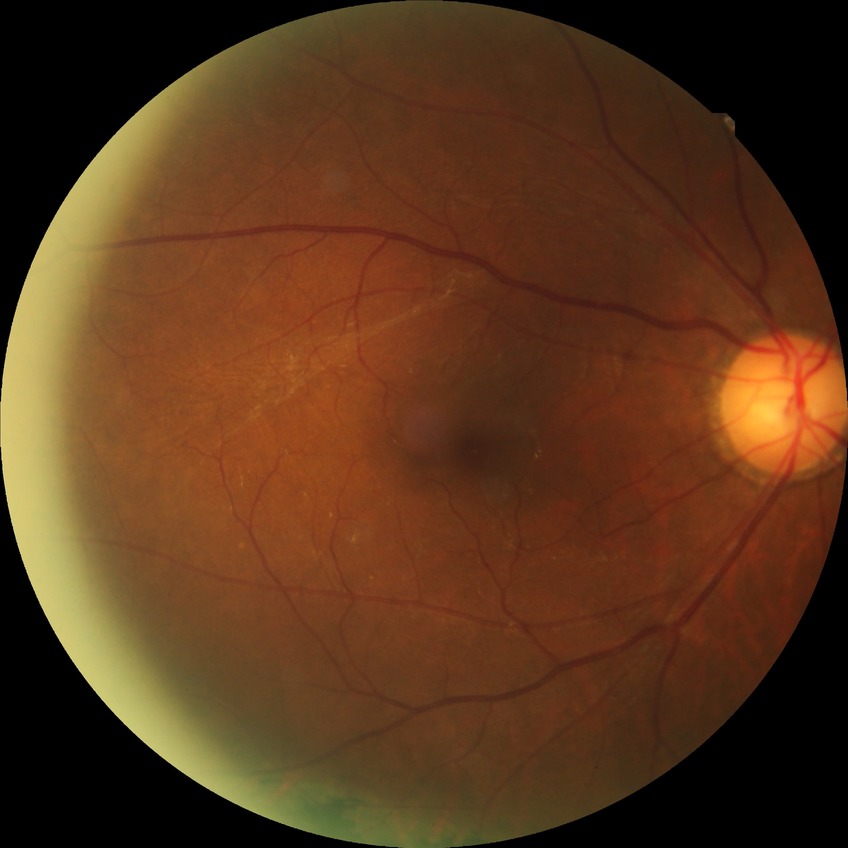

Diabetic retinopathy (DR): no diabetic retinopathy (NDR).